Modified Davis grading.
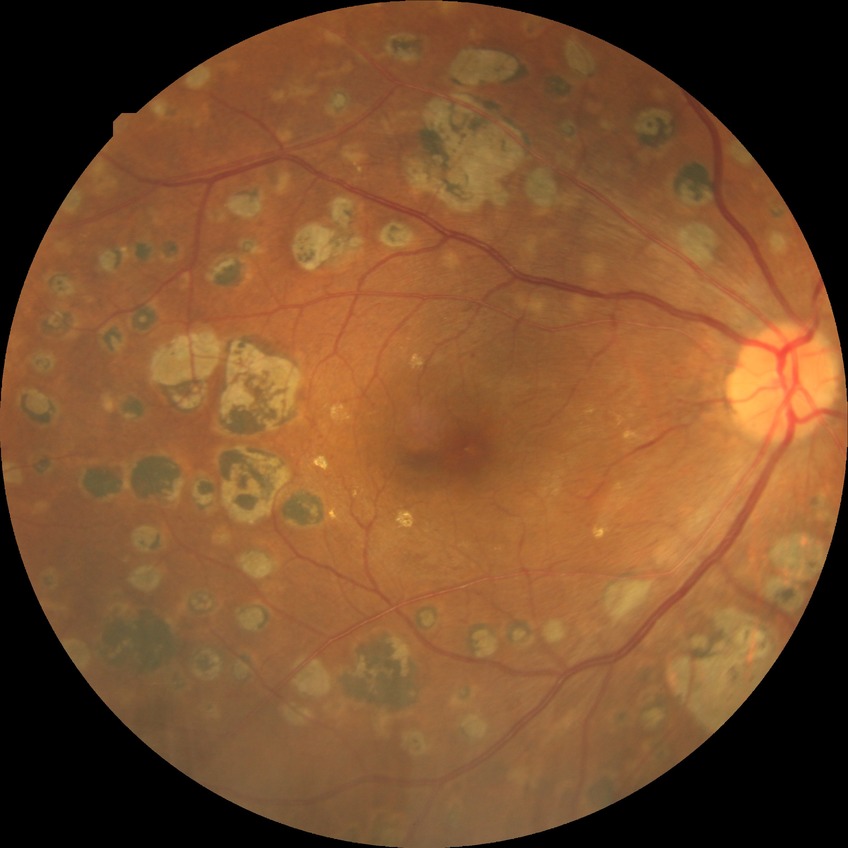 Davis grading is proliferative diabetic retinopathy.